Pupil-dilated:
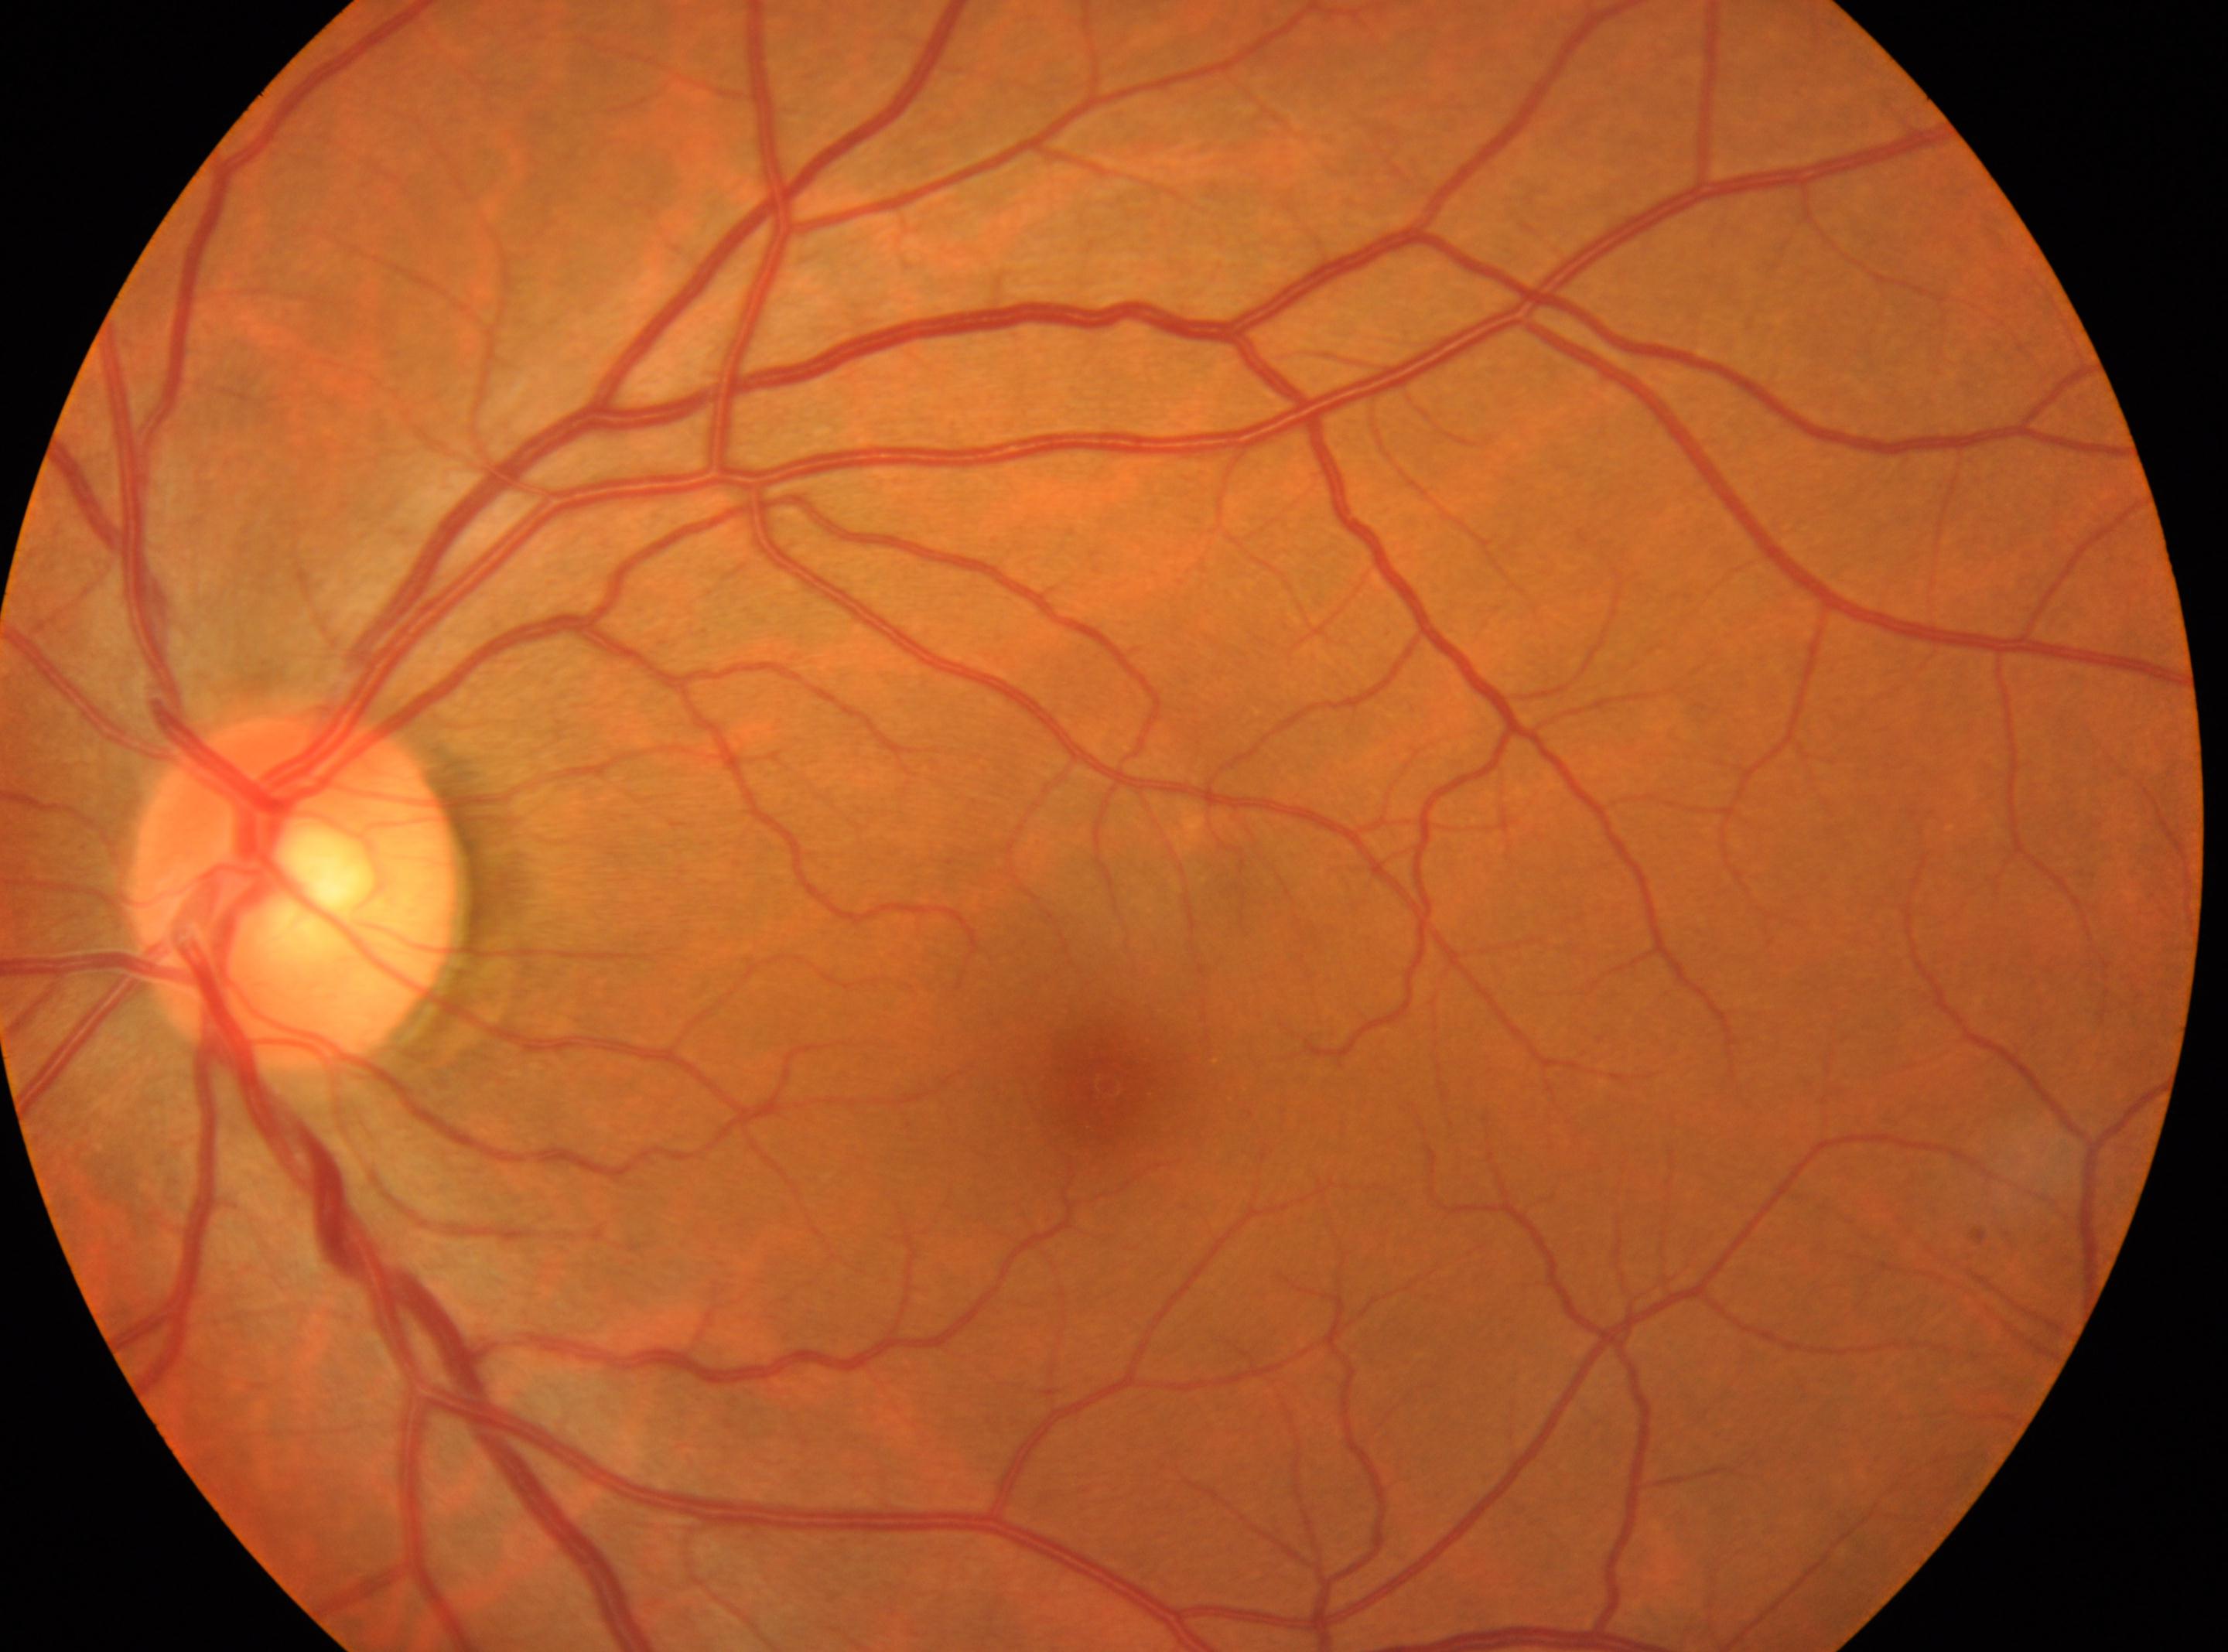 dr_grade: 0
optic_disc: x=292, y=893
eye: left
fovea: x=1108, y=1086